45° field of view
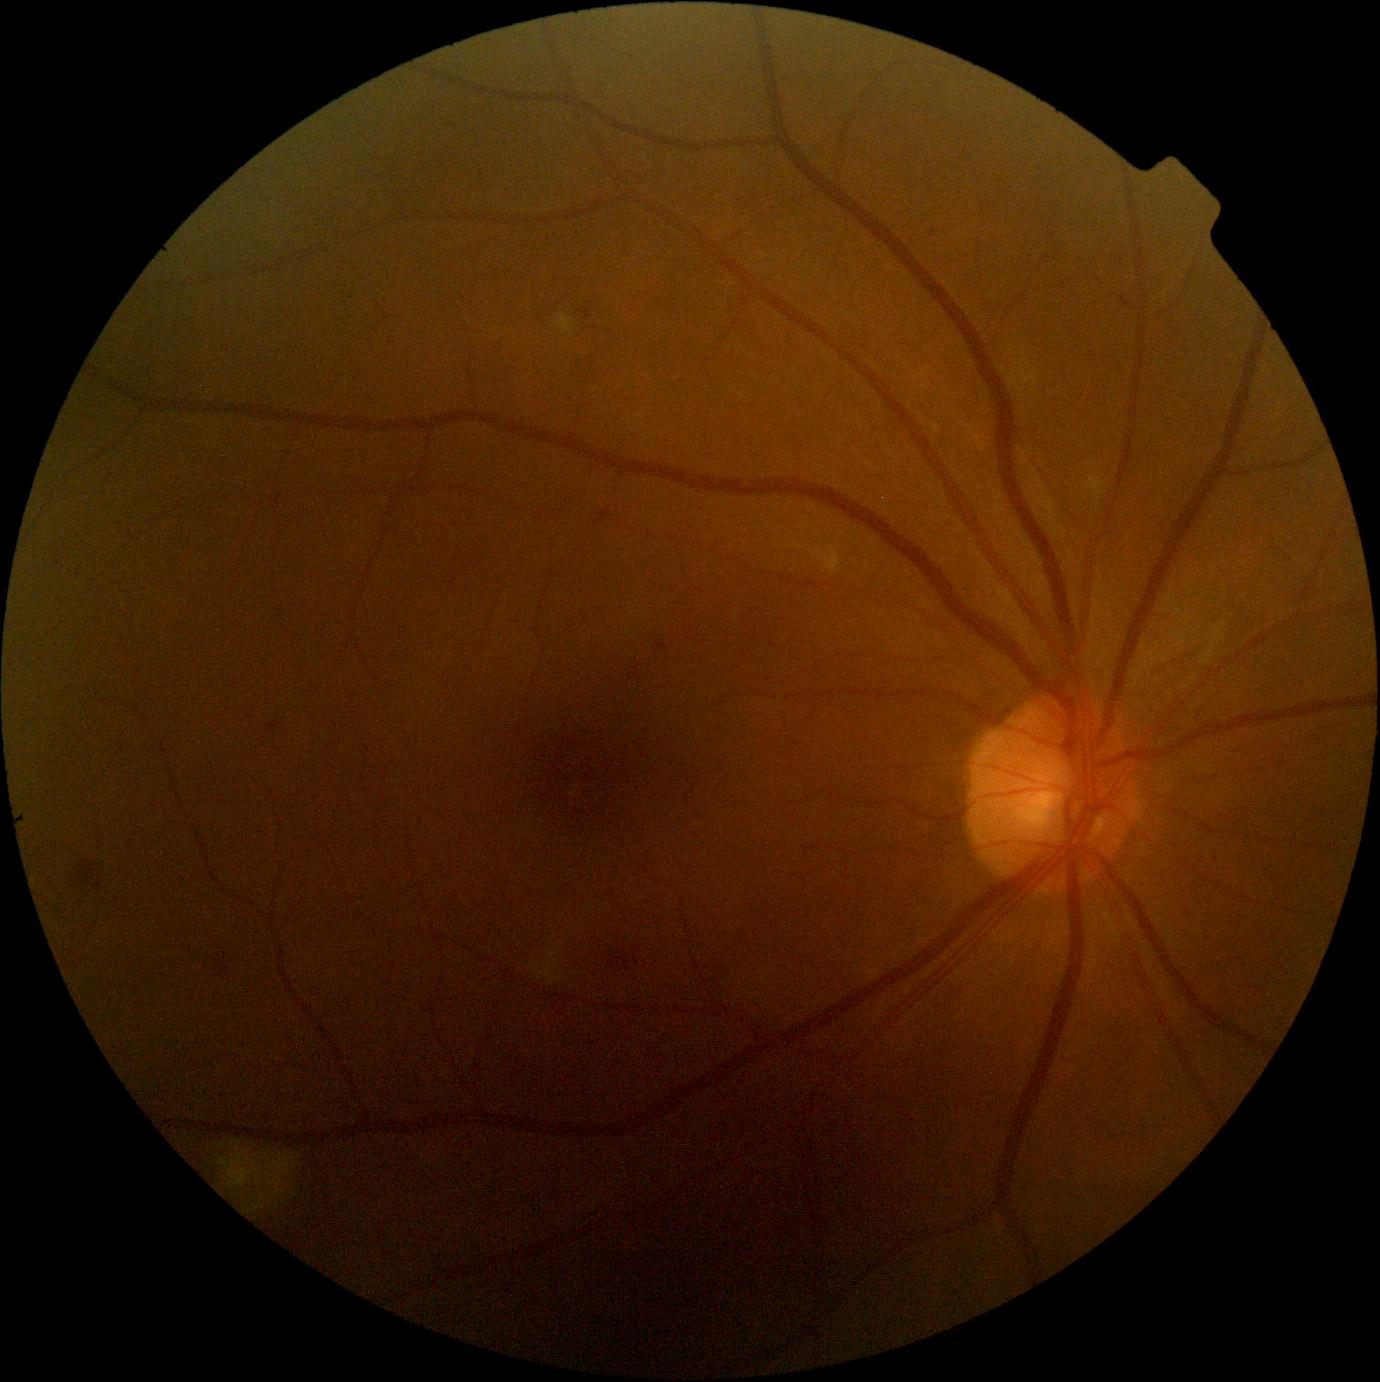

Diabetic retinopathy (DR): grade 2 (moderate NPDR) — more than just microaneurysms but less than severe NPDR.